2352x1568px, 45-degree field of view, fundus photo: 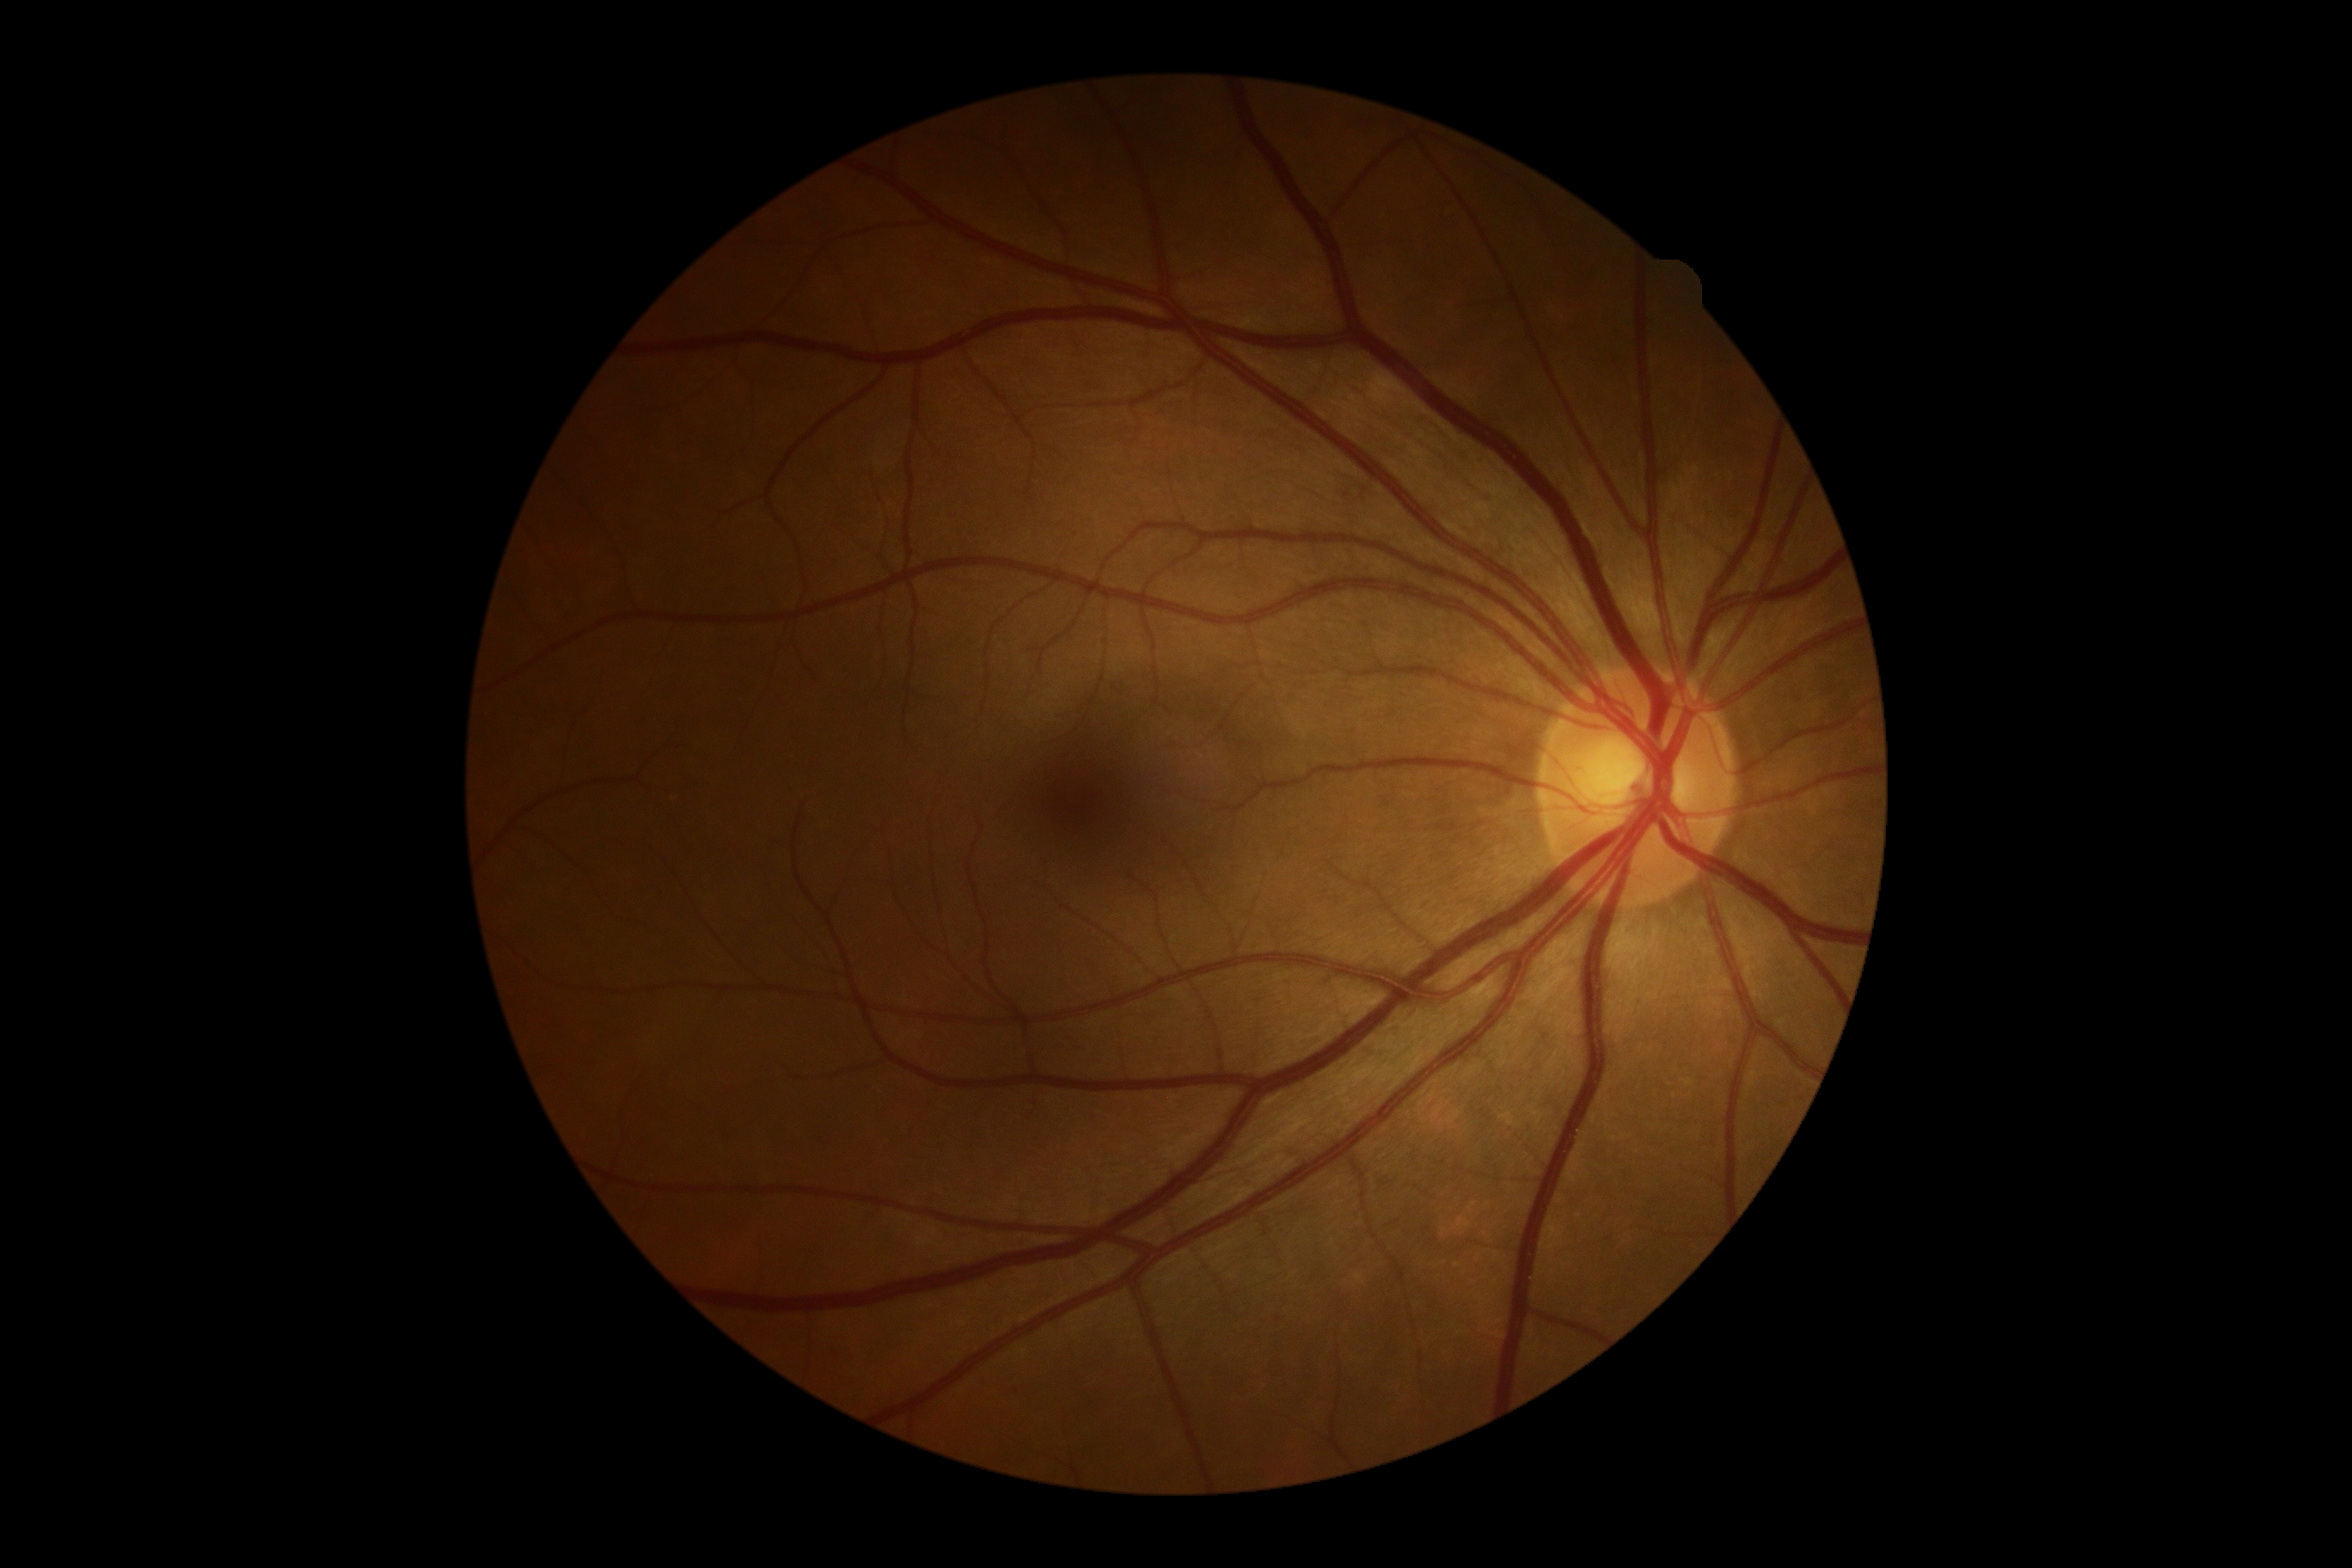

diabetic retinopathy (DR): grade 0.